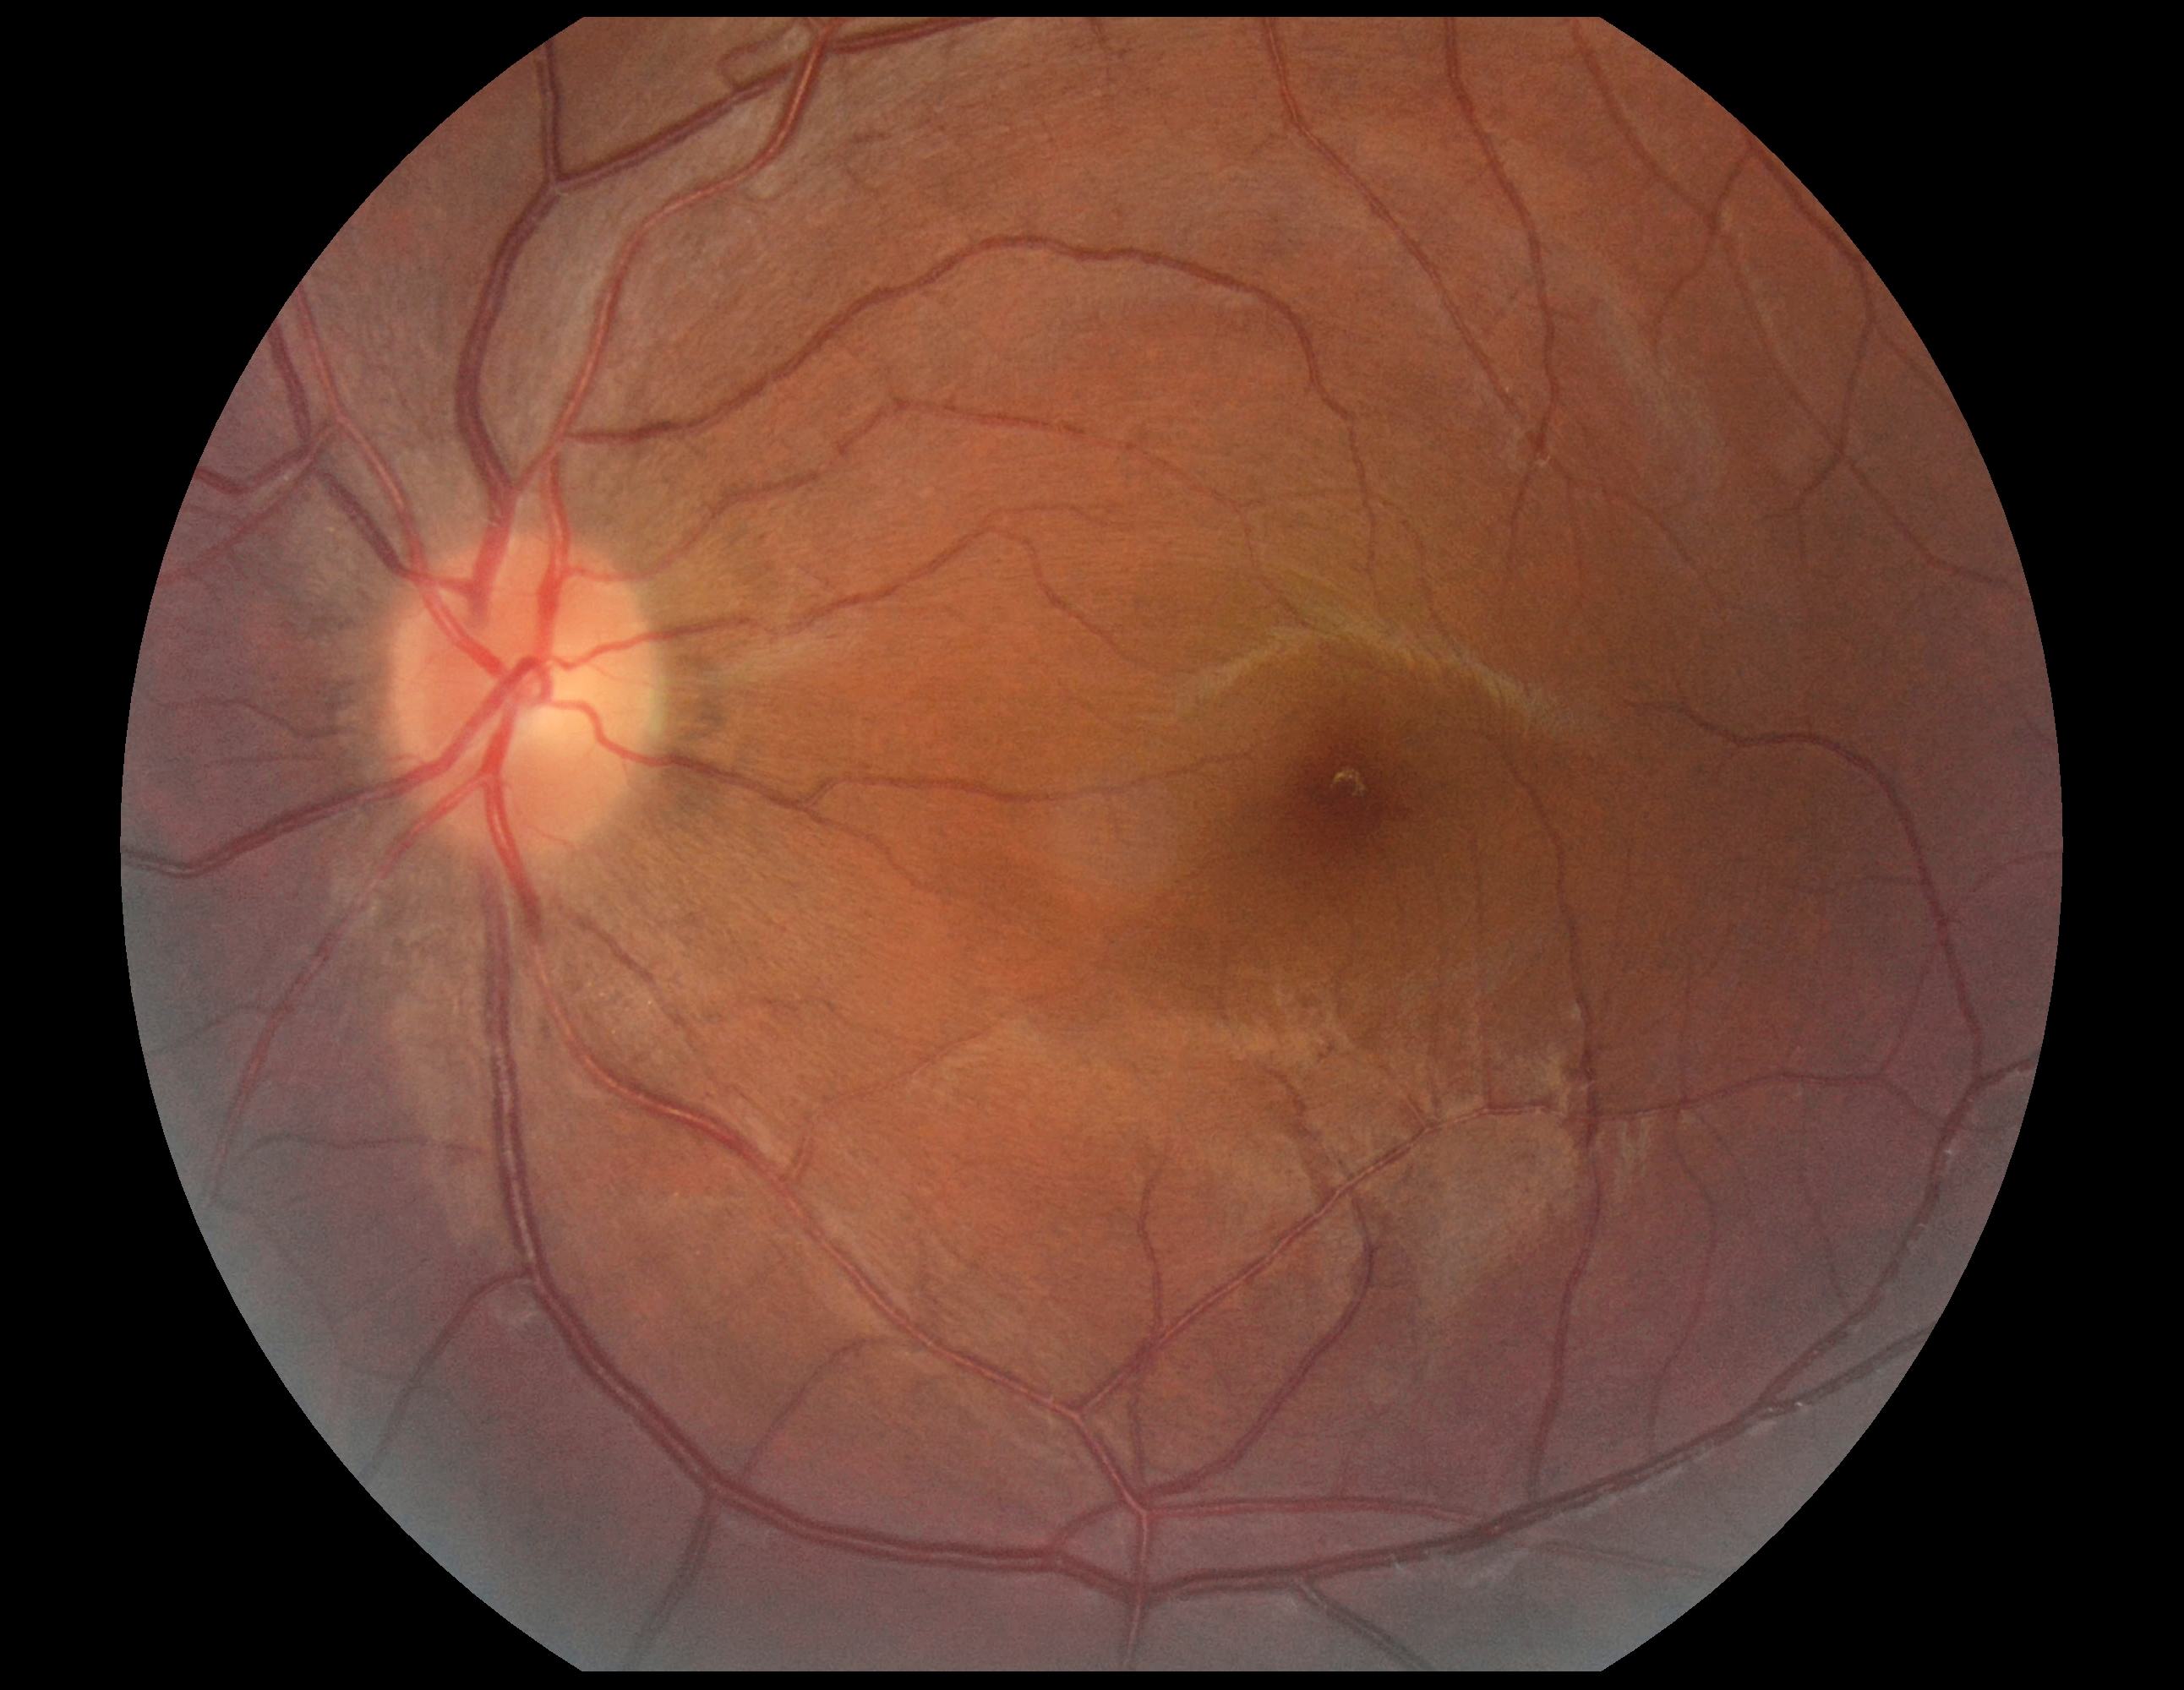
Findings:
* diabetic retinopathy grade — no apparent diabetic retinopathy (0)